Graded on the modified Davis scale. Nonmydriatic
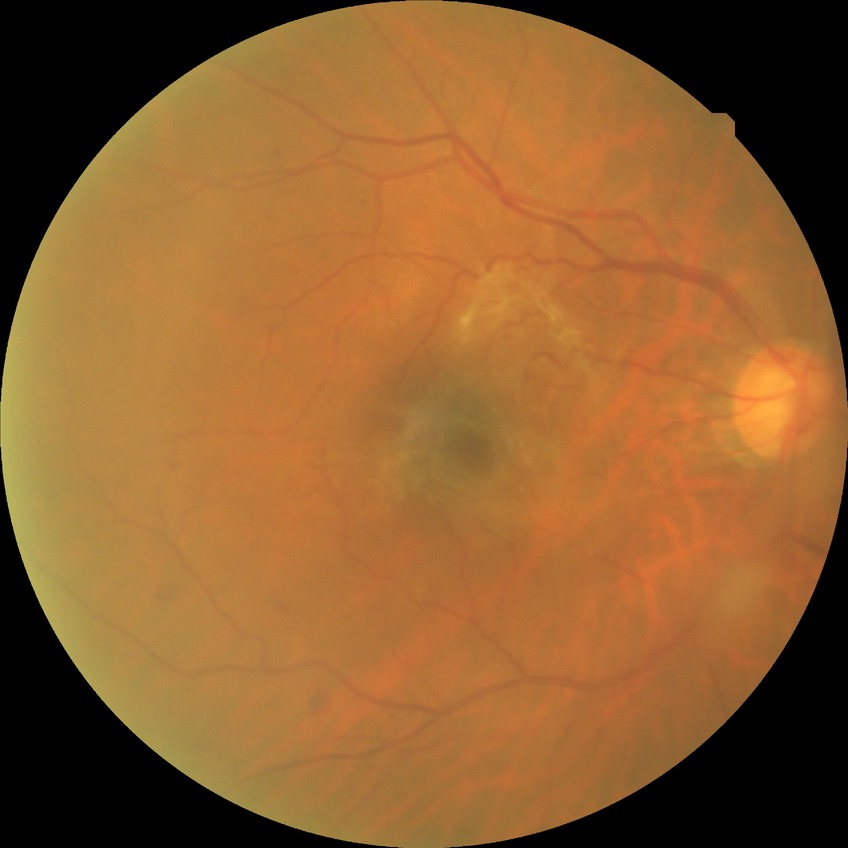
Modified Davis grading: simple diabetic retinopathy.